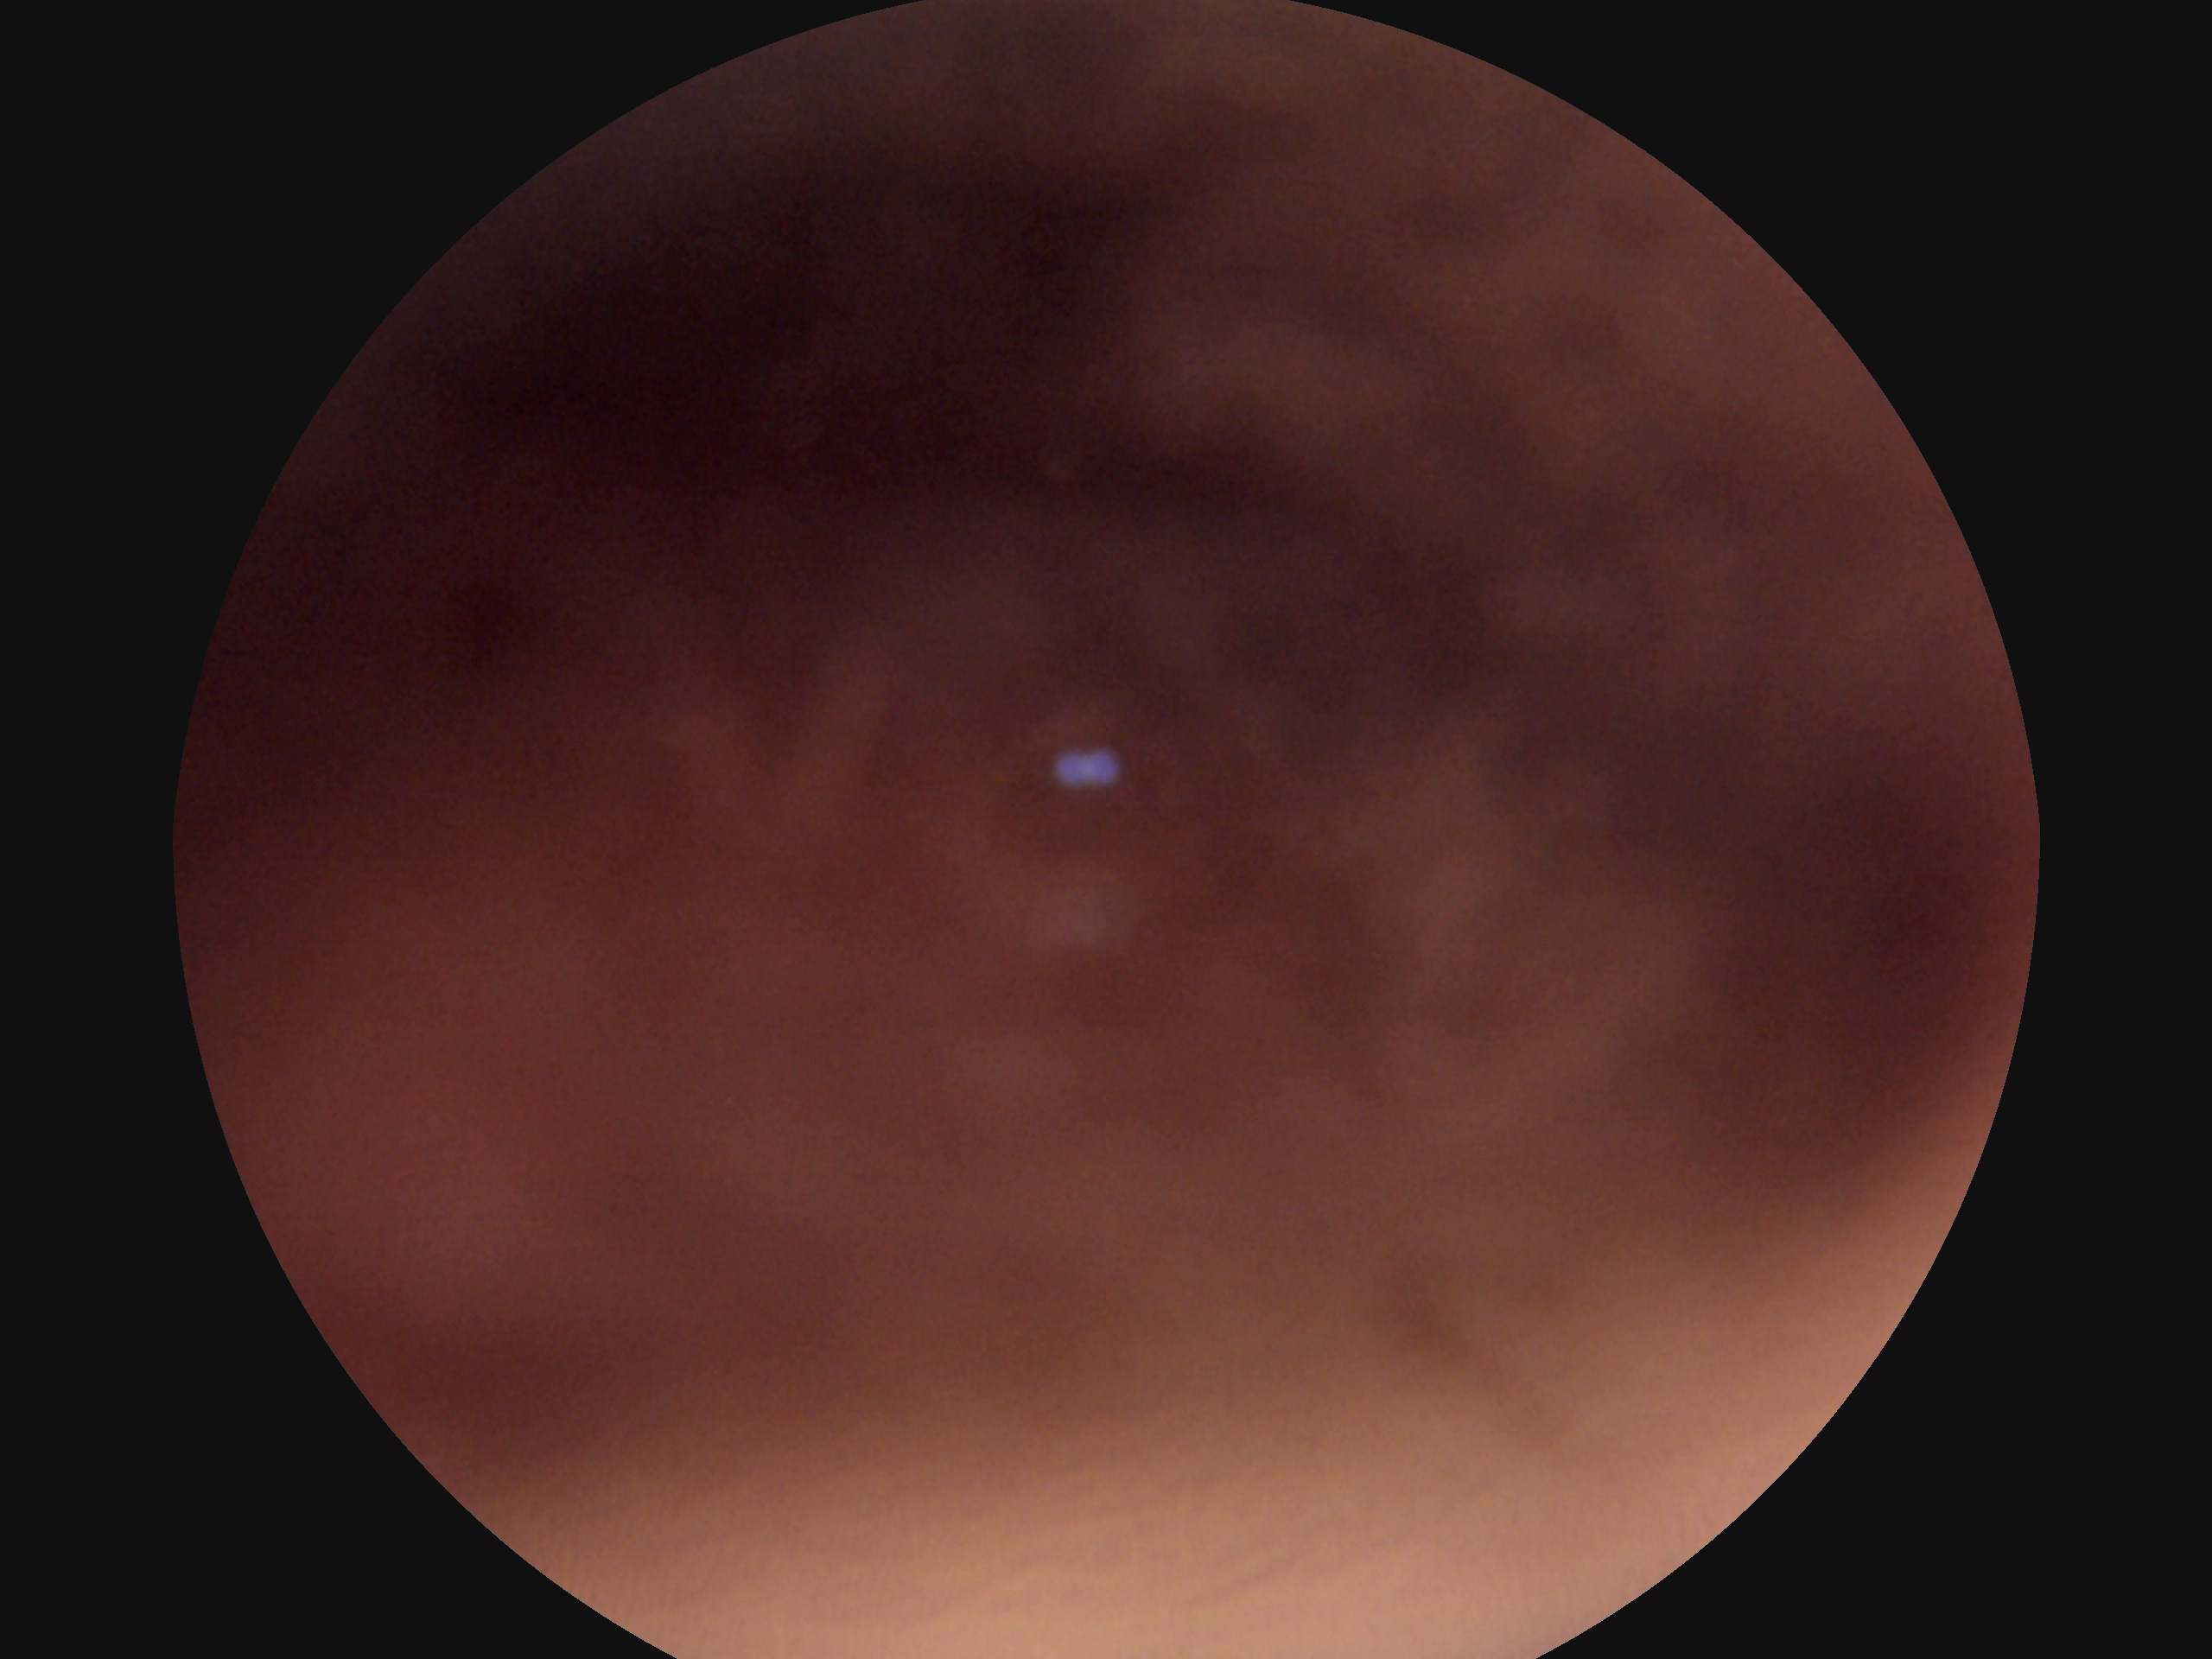
diabetic retinopathy = ungradable
image quality = insufficient